Wide-field contact fundus photograph of an infant.
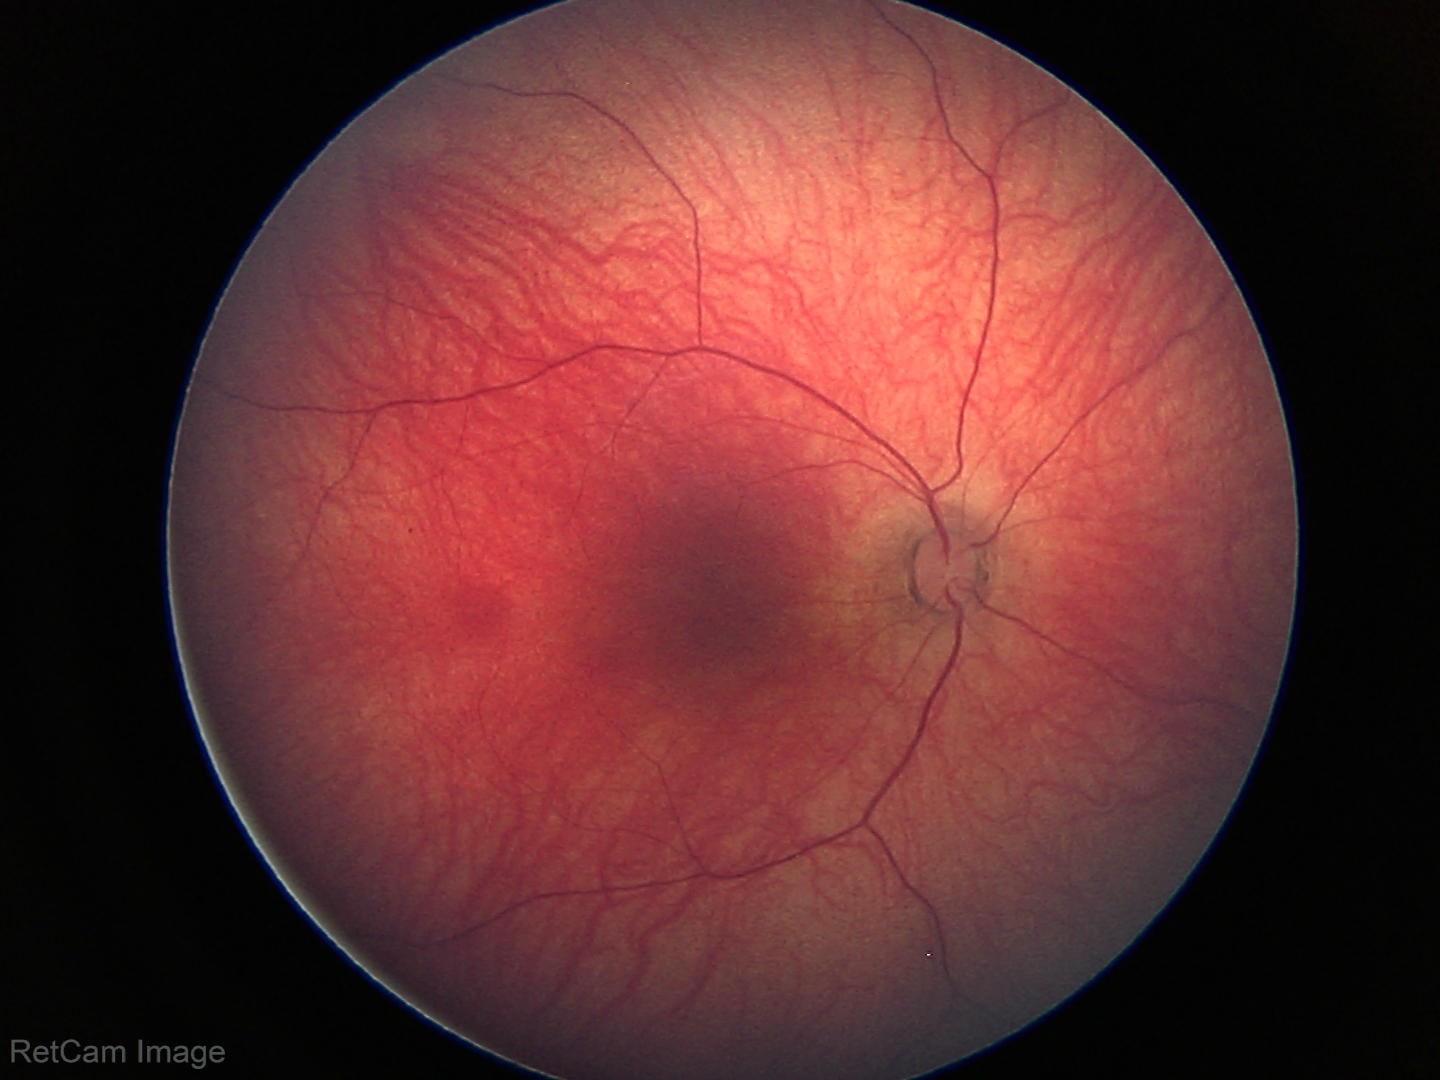

Screening examination with no abnormal retinal findings.